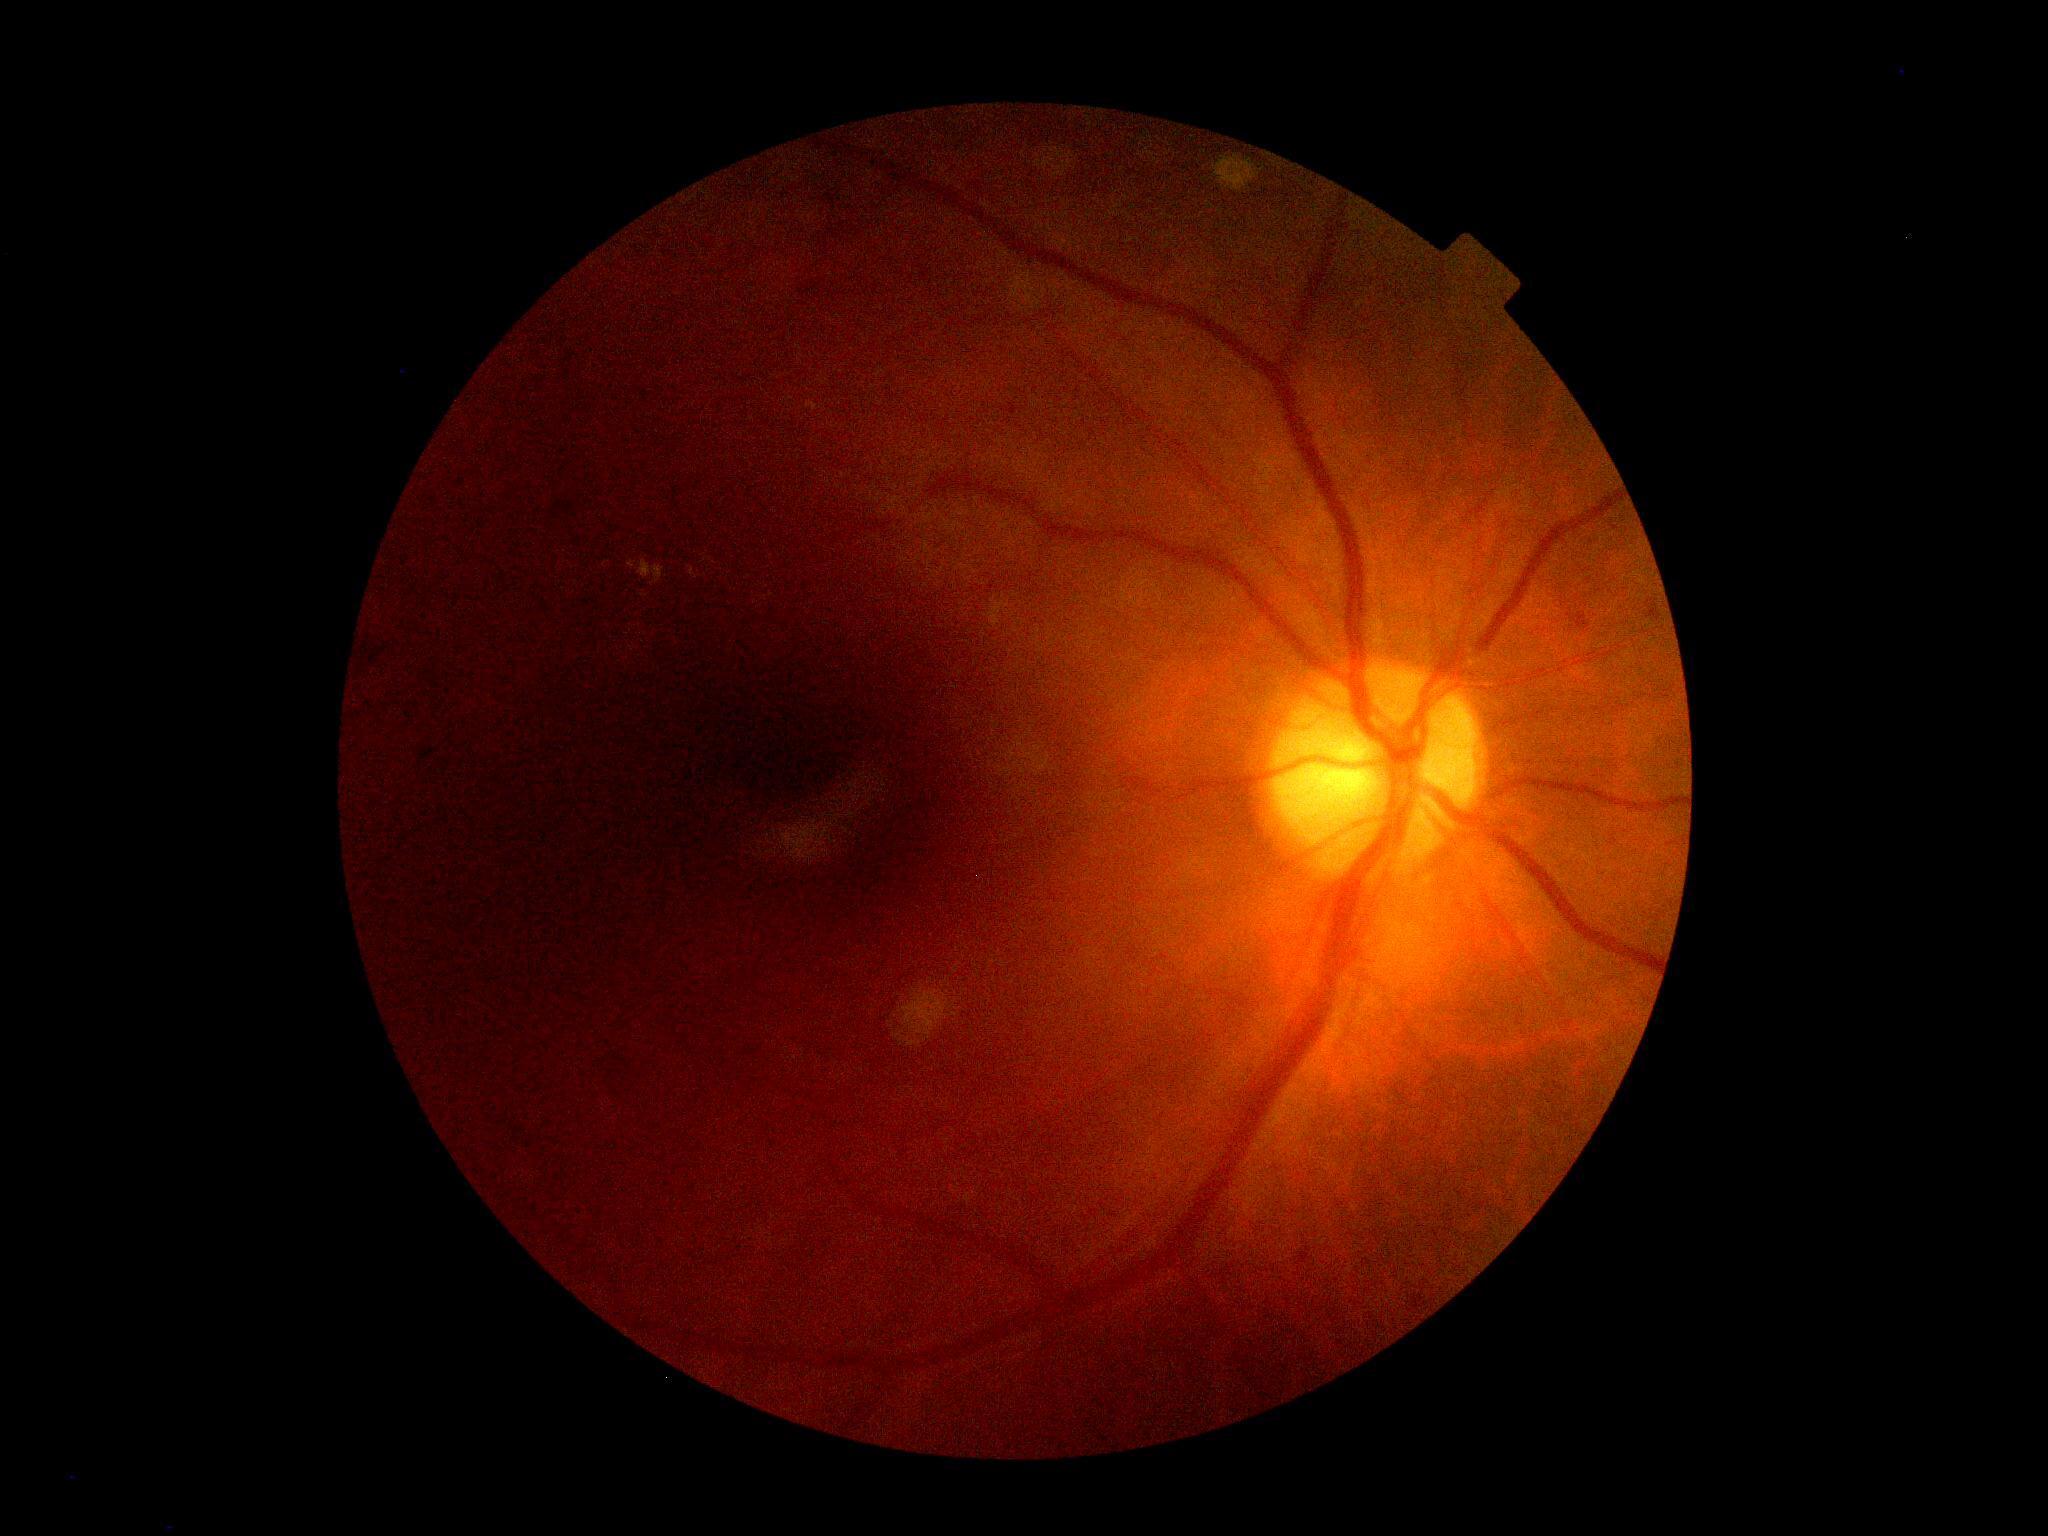

Diabetic retinopathy severity: 2/4.